Camera: NIDEK AFC-230; nonmydriatic; modified Davis grading; 45-degree field of view; posterior pole color fundus photograph; 848 x 848 pixels
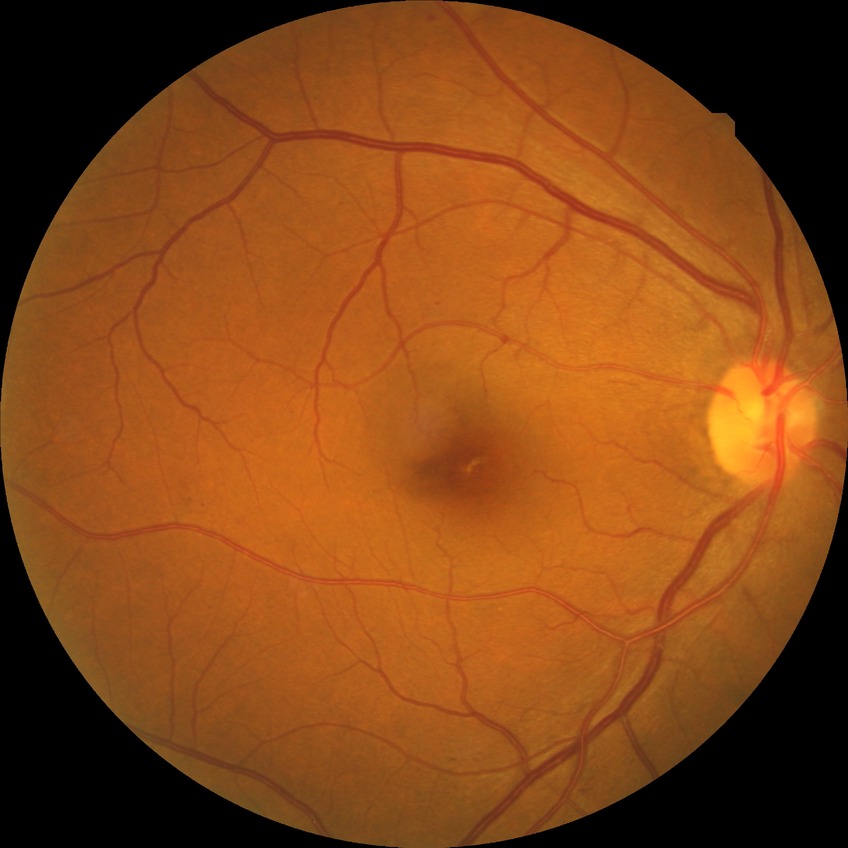
Diabetic retinopathy (DR): SDR (simple diabetic retinopathy).